Image size 1240x1240; pediatric retinal photograph (wide-field).
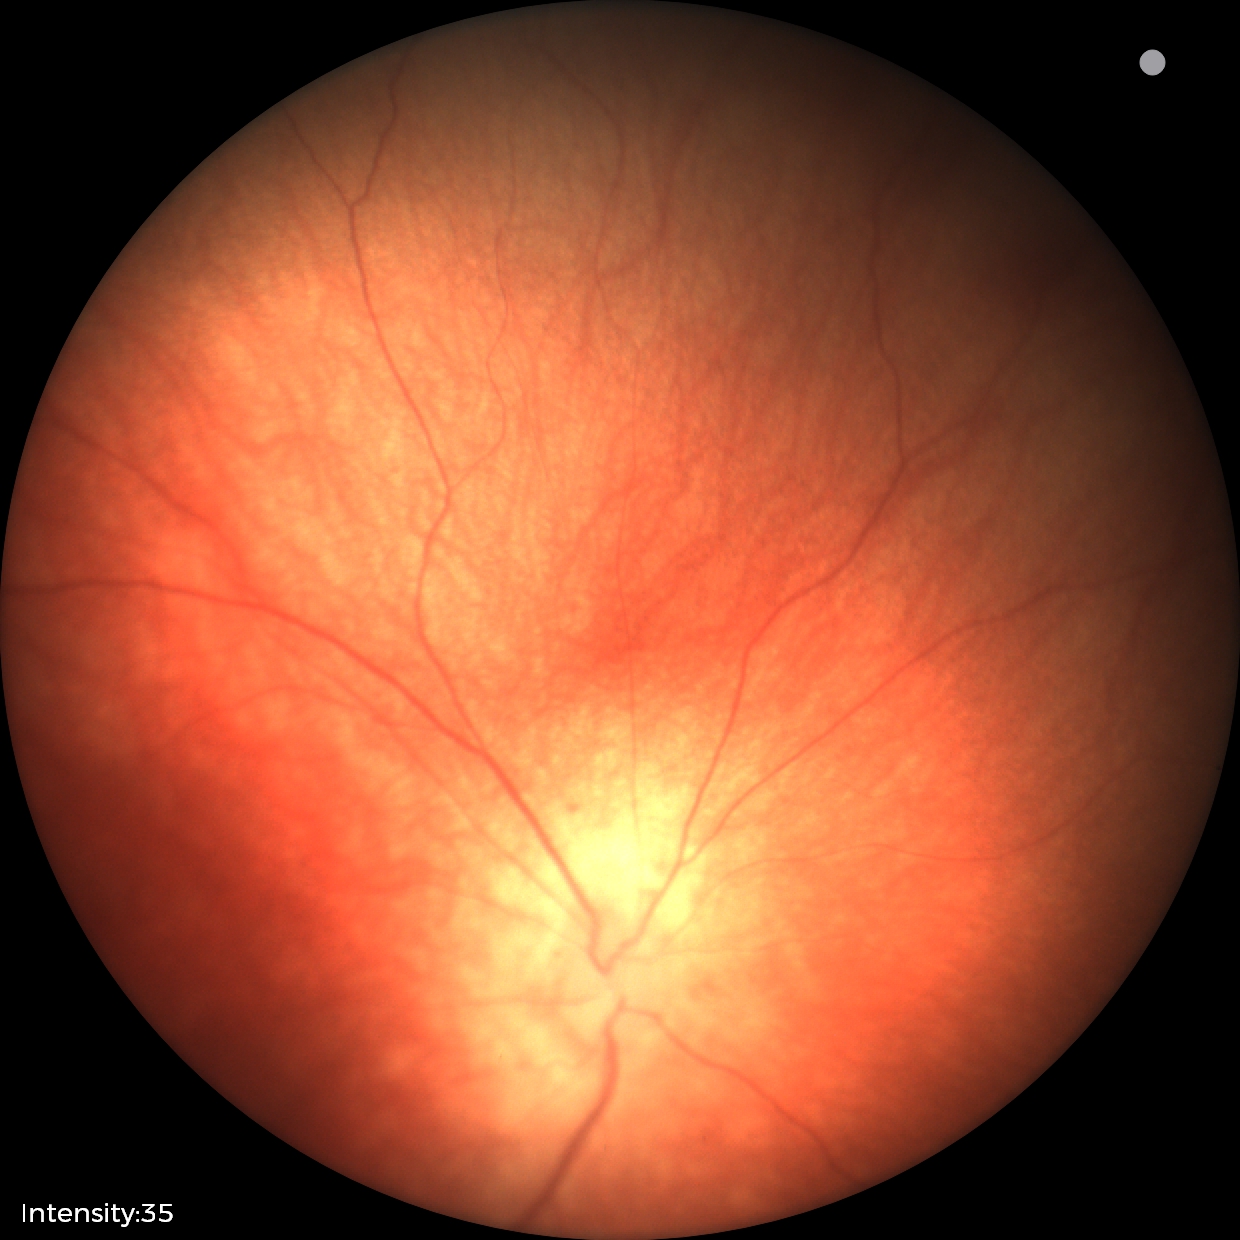

Screening examination with no abnormal retinal findings.